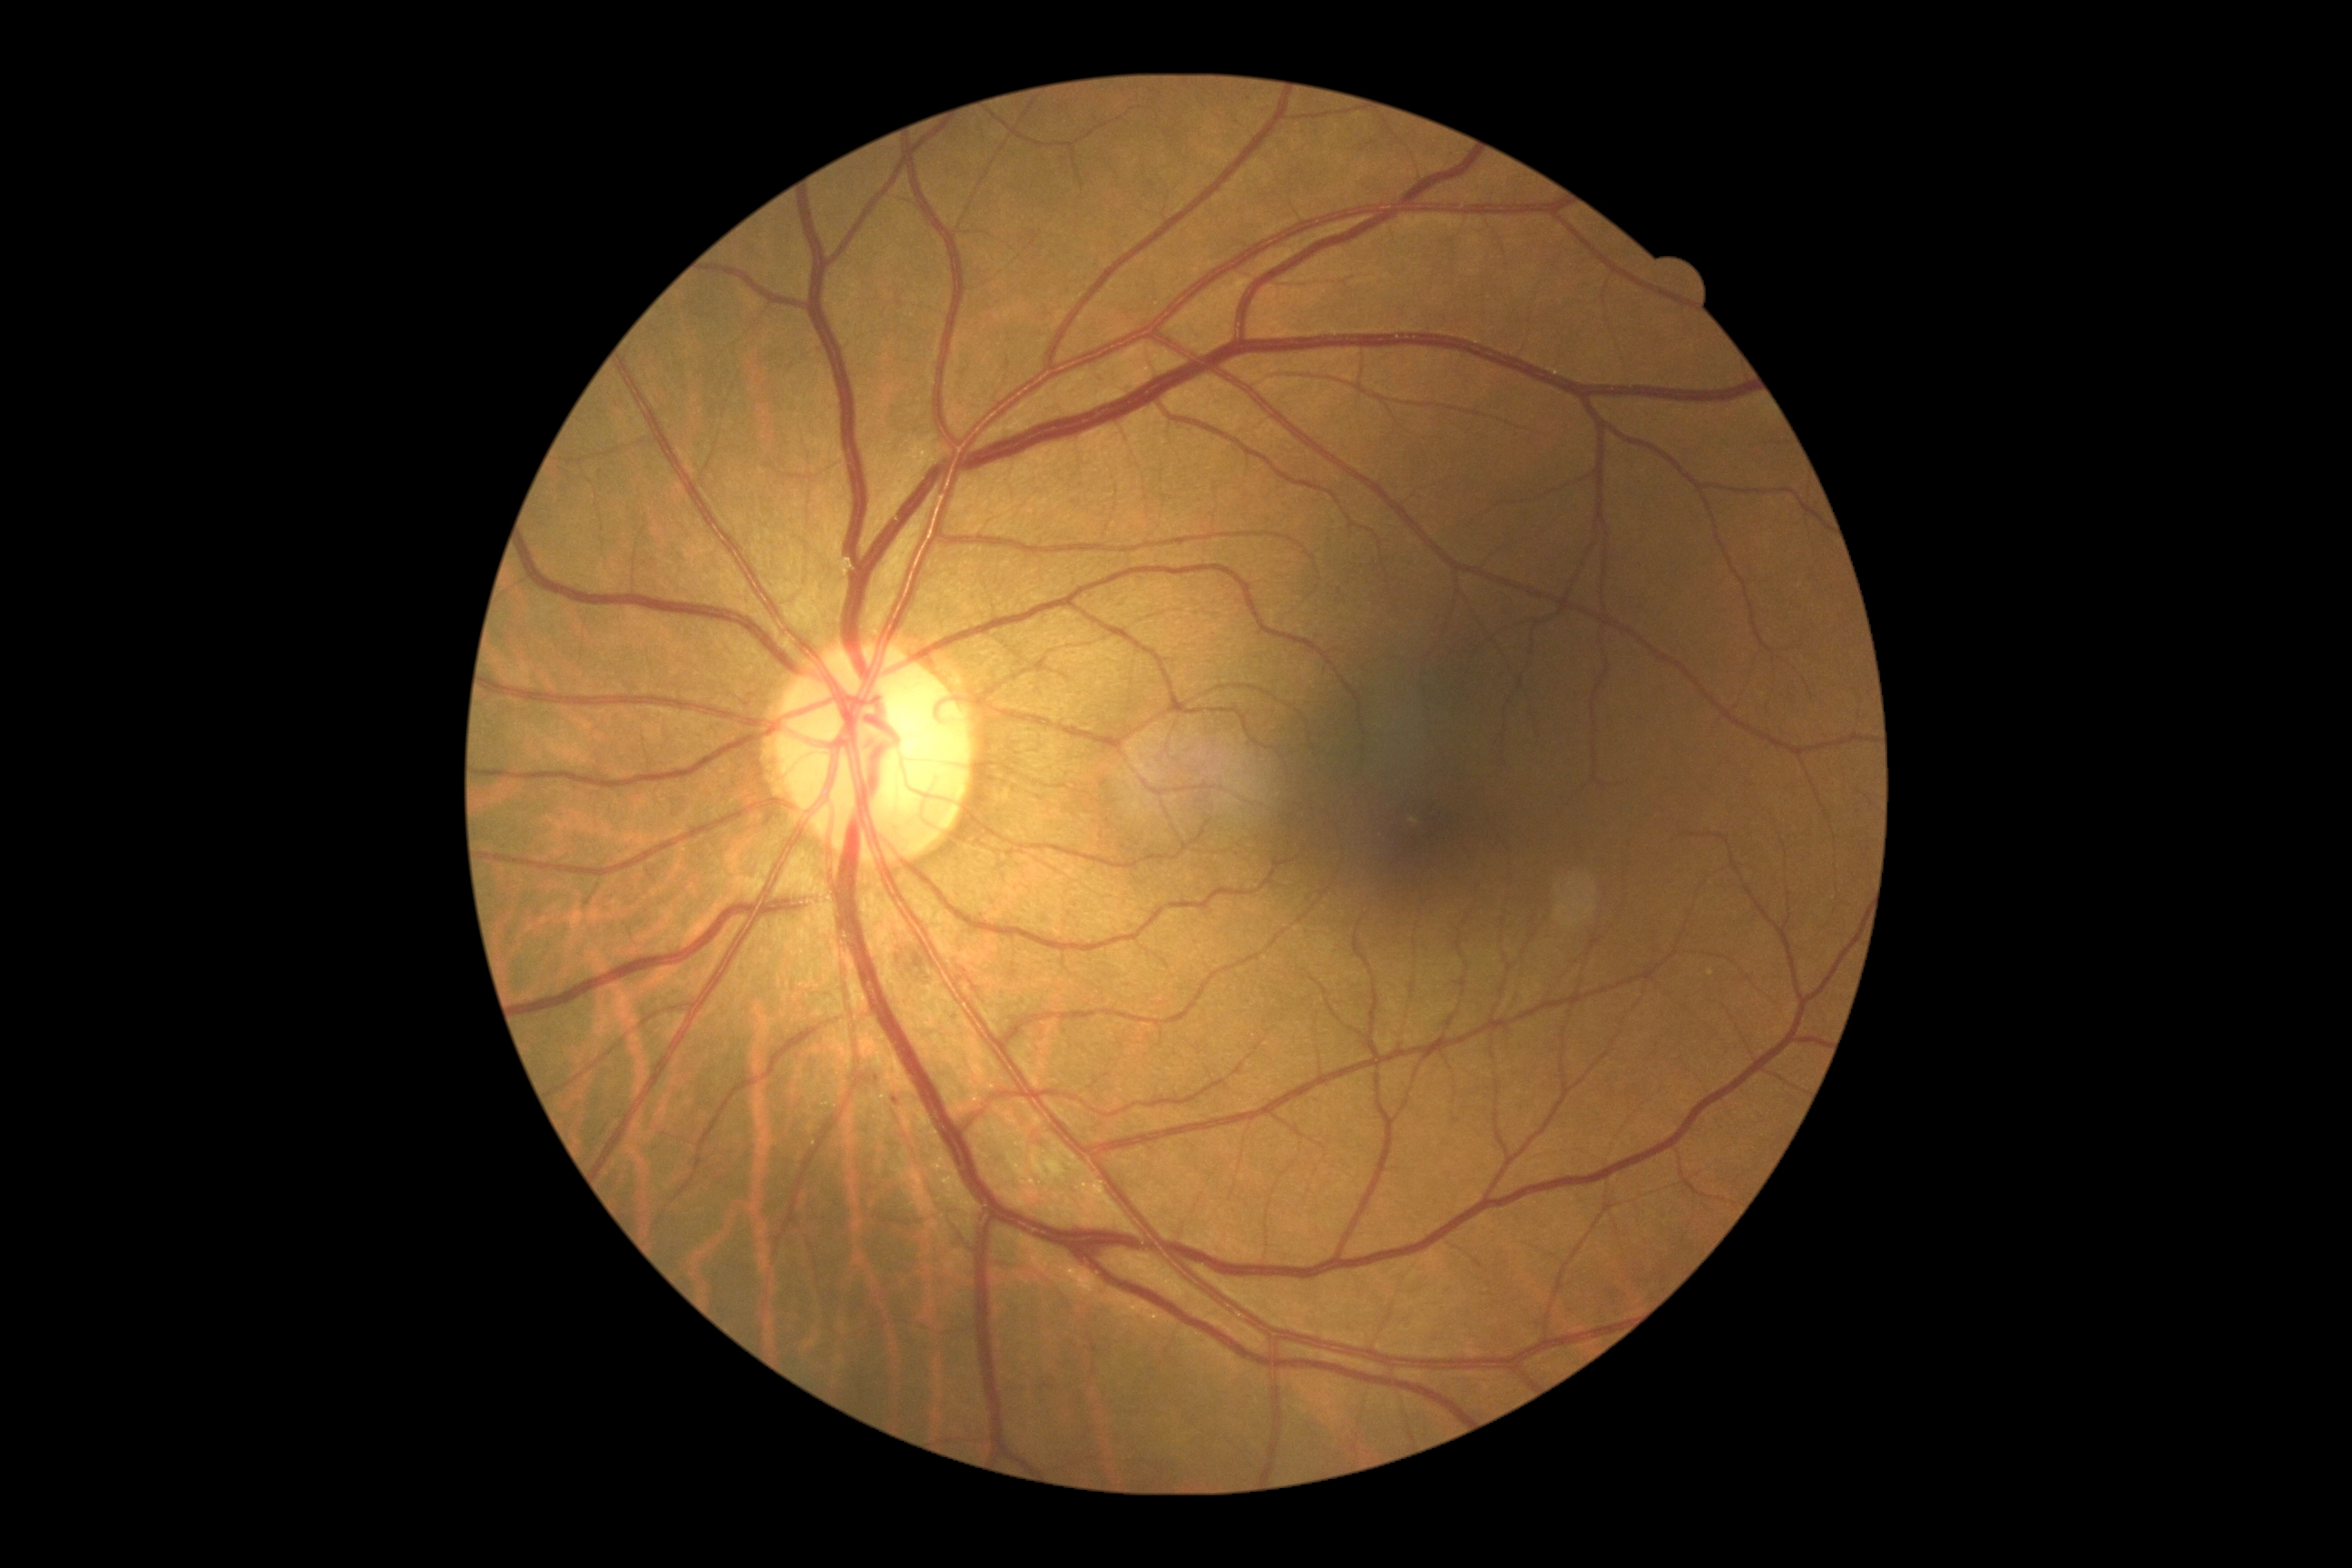 – retinopathy — grade 2